Captured with the Phoenix ICON (100° field of view); infant wide-field fundus photograph
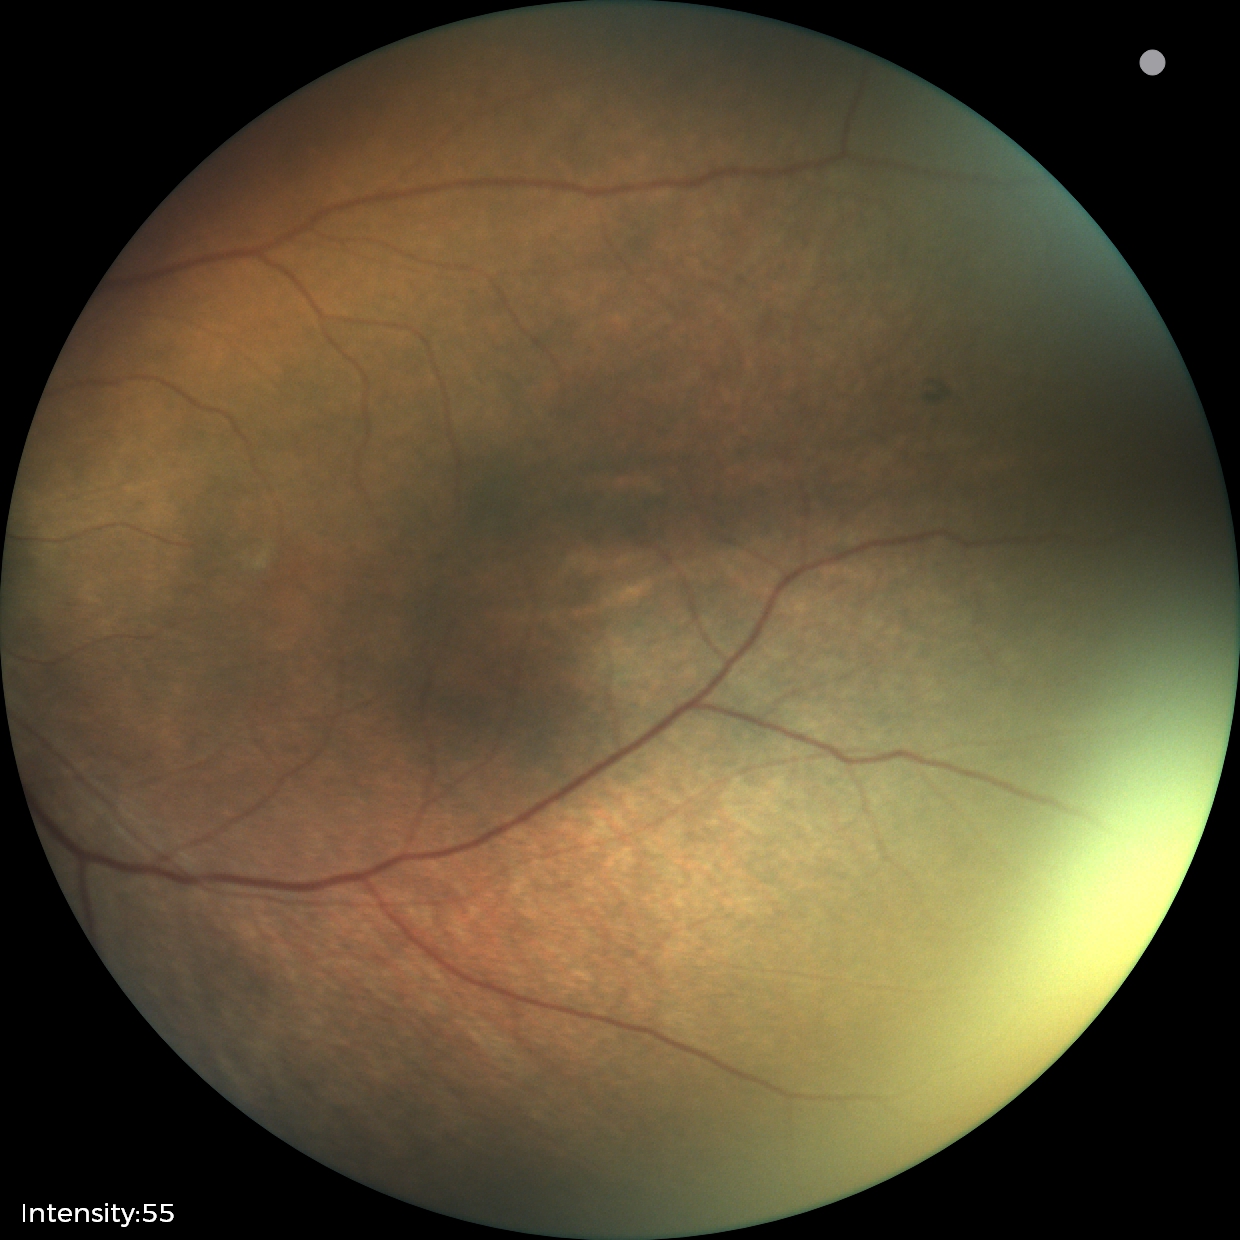

Assessment: status post retinopathy of prematurity.